Nonmydriatic. 45° FOV — 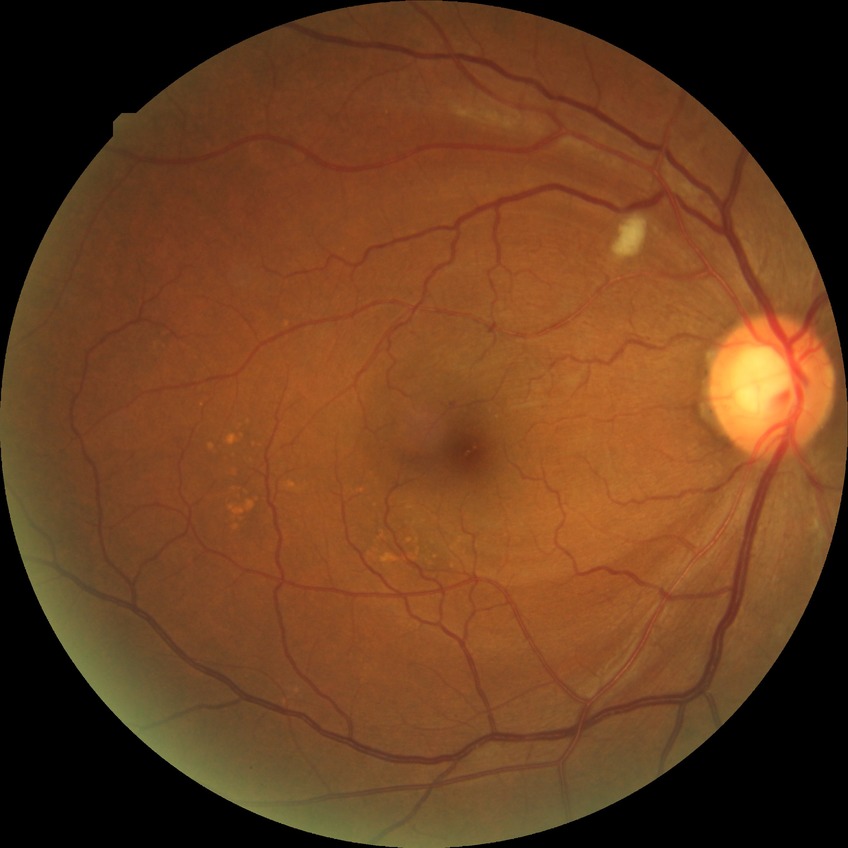 Modified Davis classification: pre-proliferative diabetic retinopathy.
Disease class: non-proliferative diabetic retinopathy.